1932 by 1923 pixels; 45-degree field of view; fundus photo: 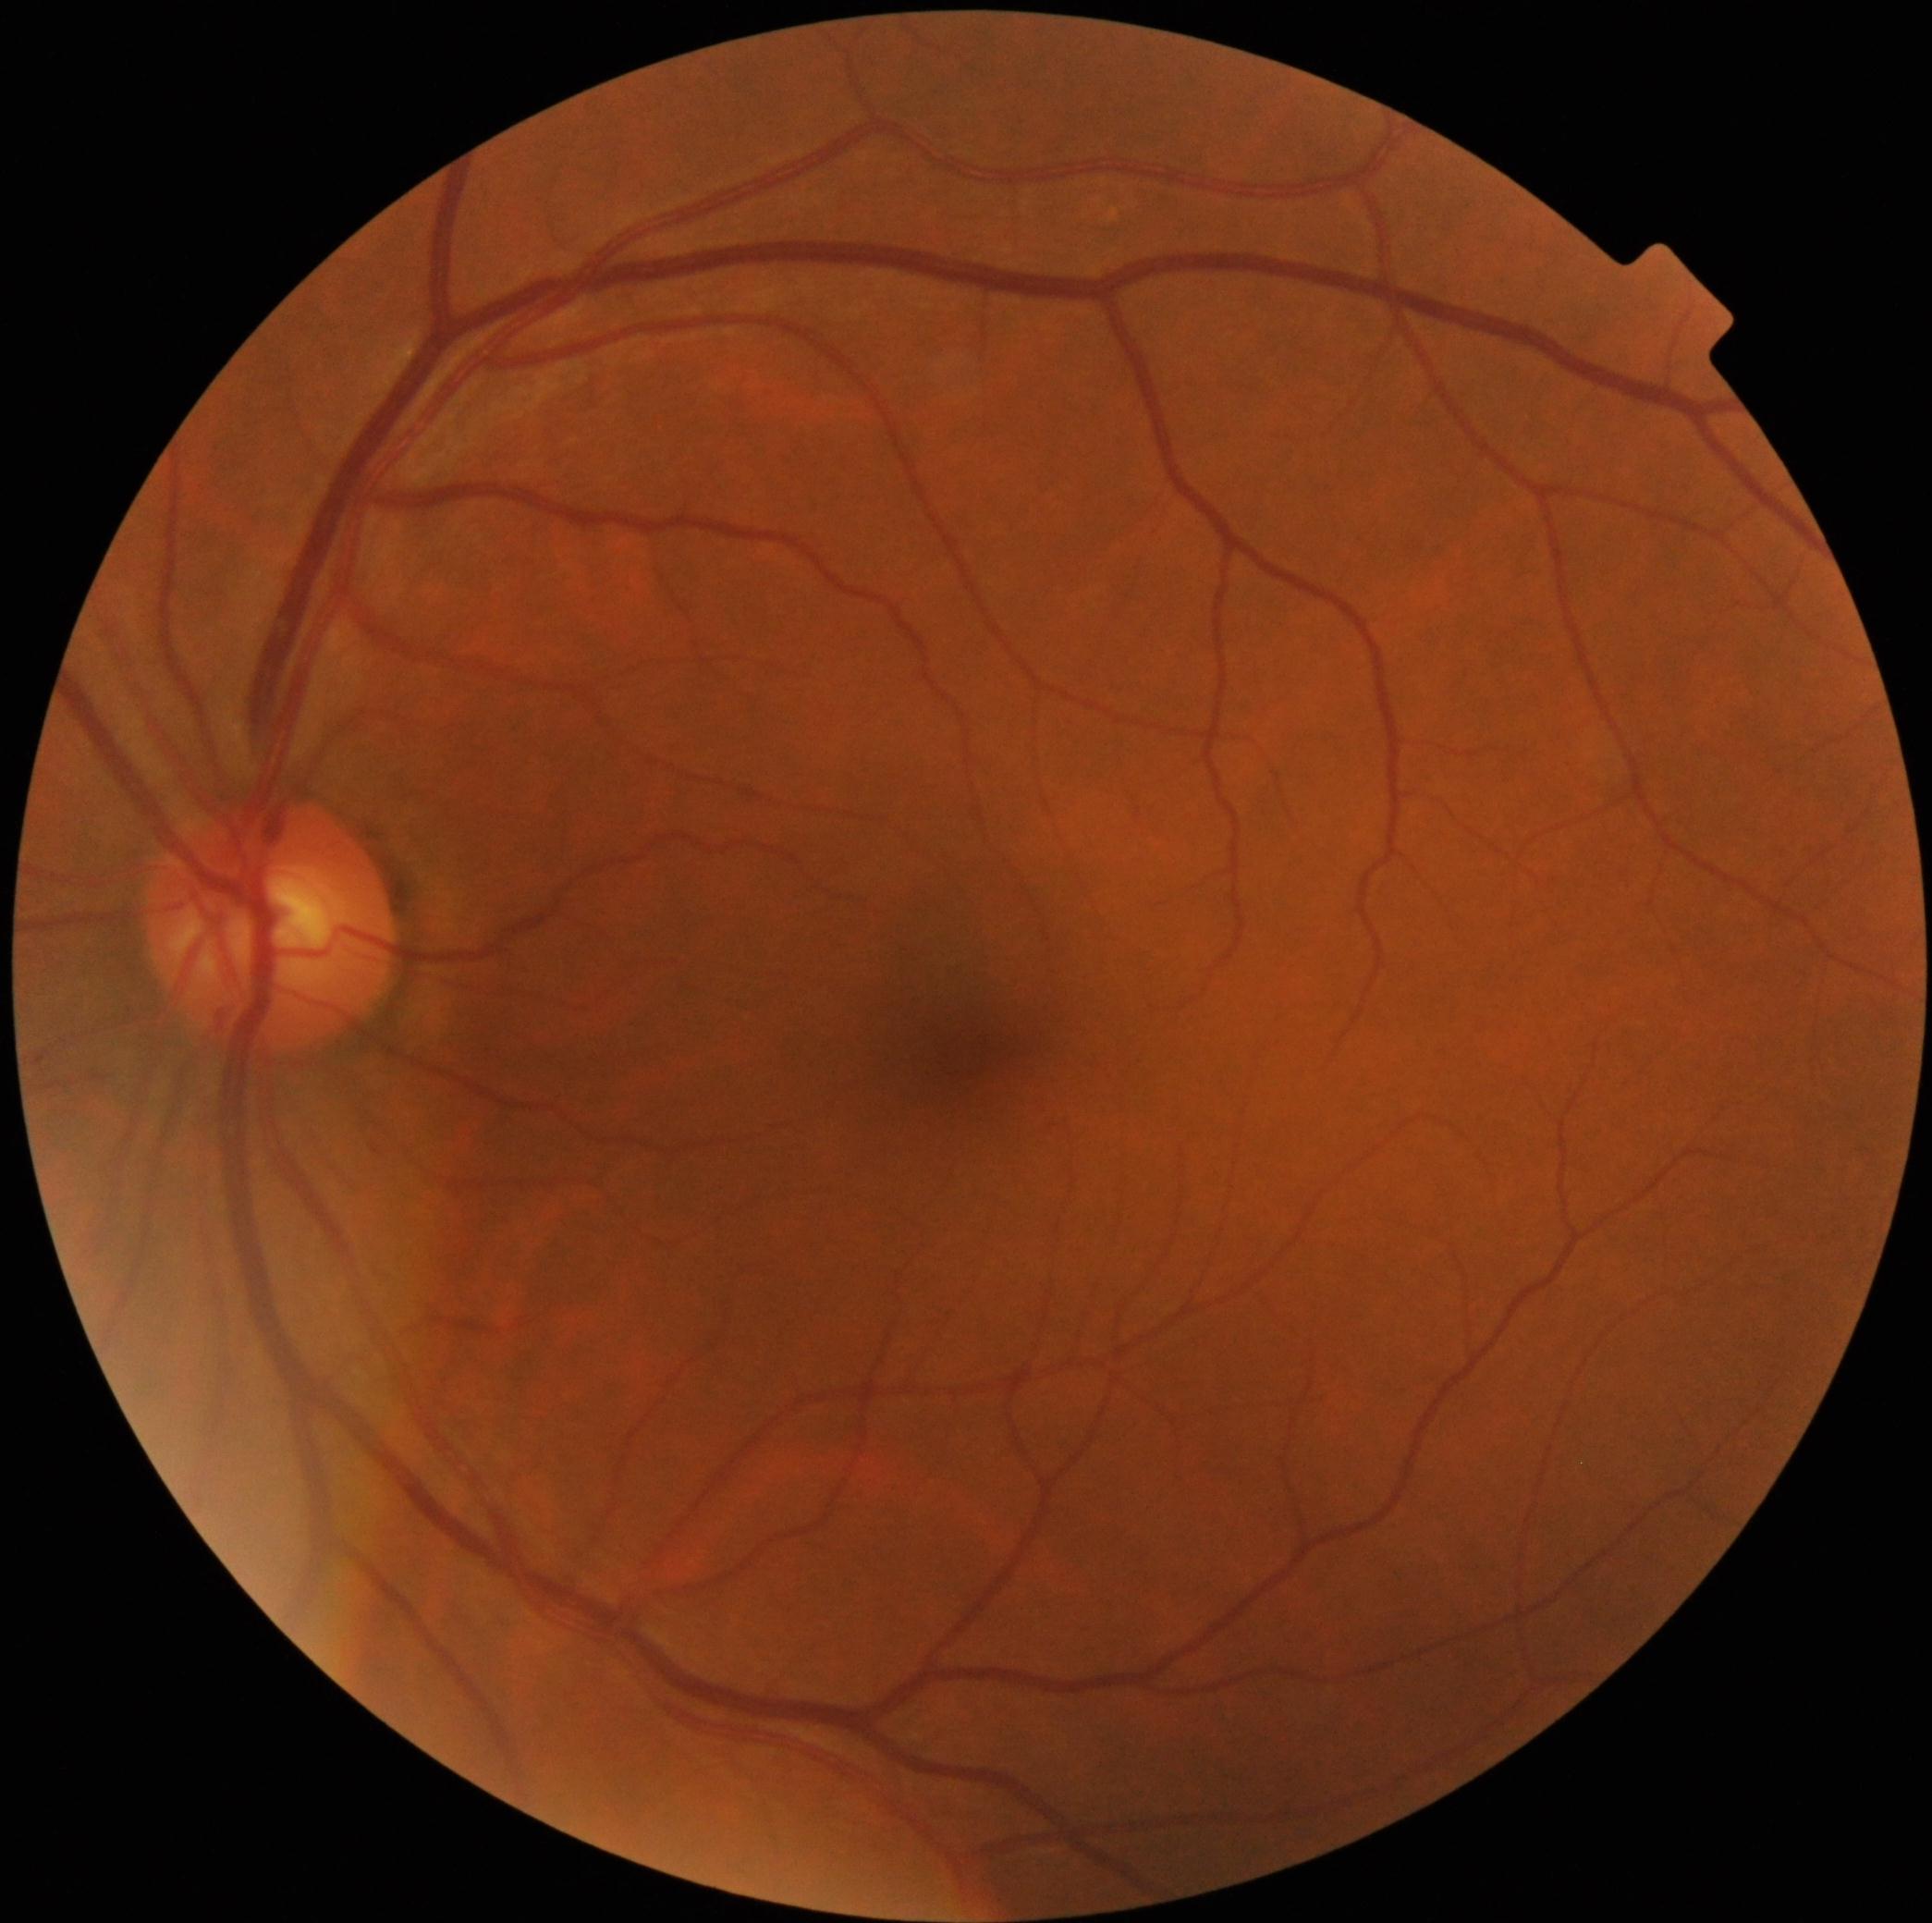

DR severity: grade 0 (no apparent retinopathy).